848x848px:
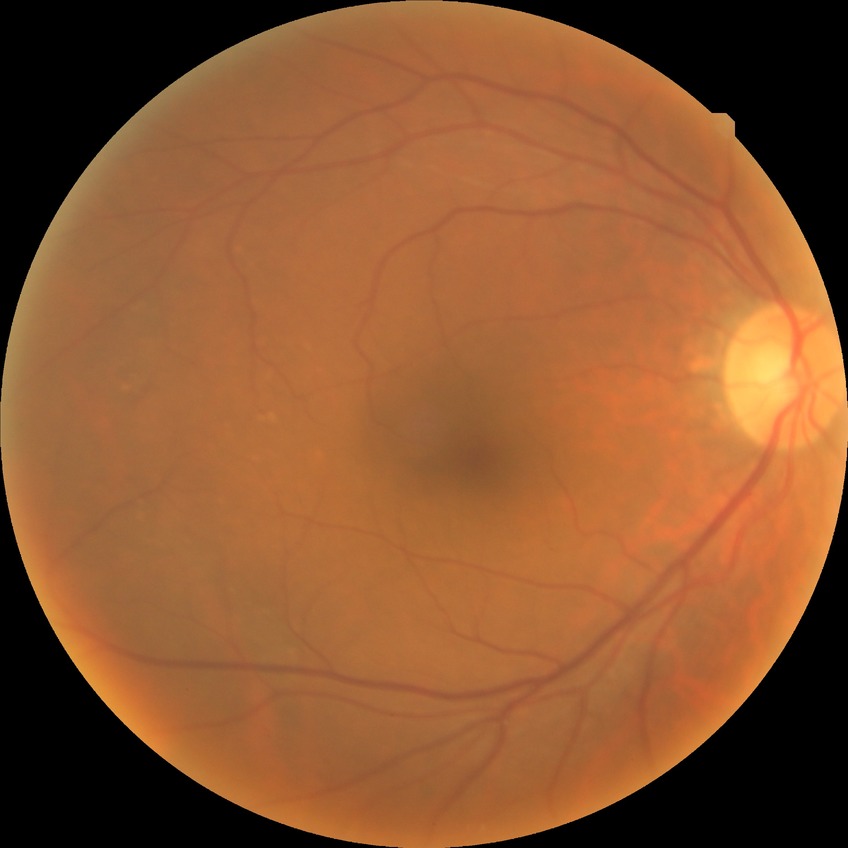

Modified Davis grade is NDR.